2352x1568px — 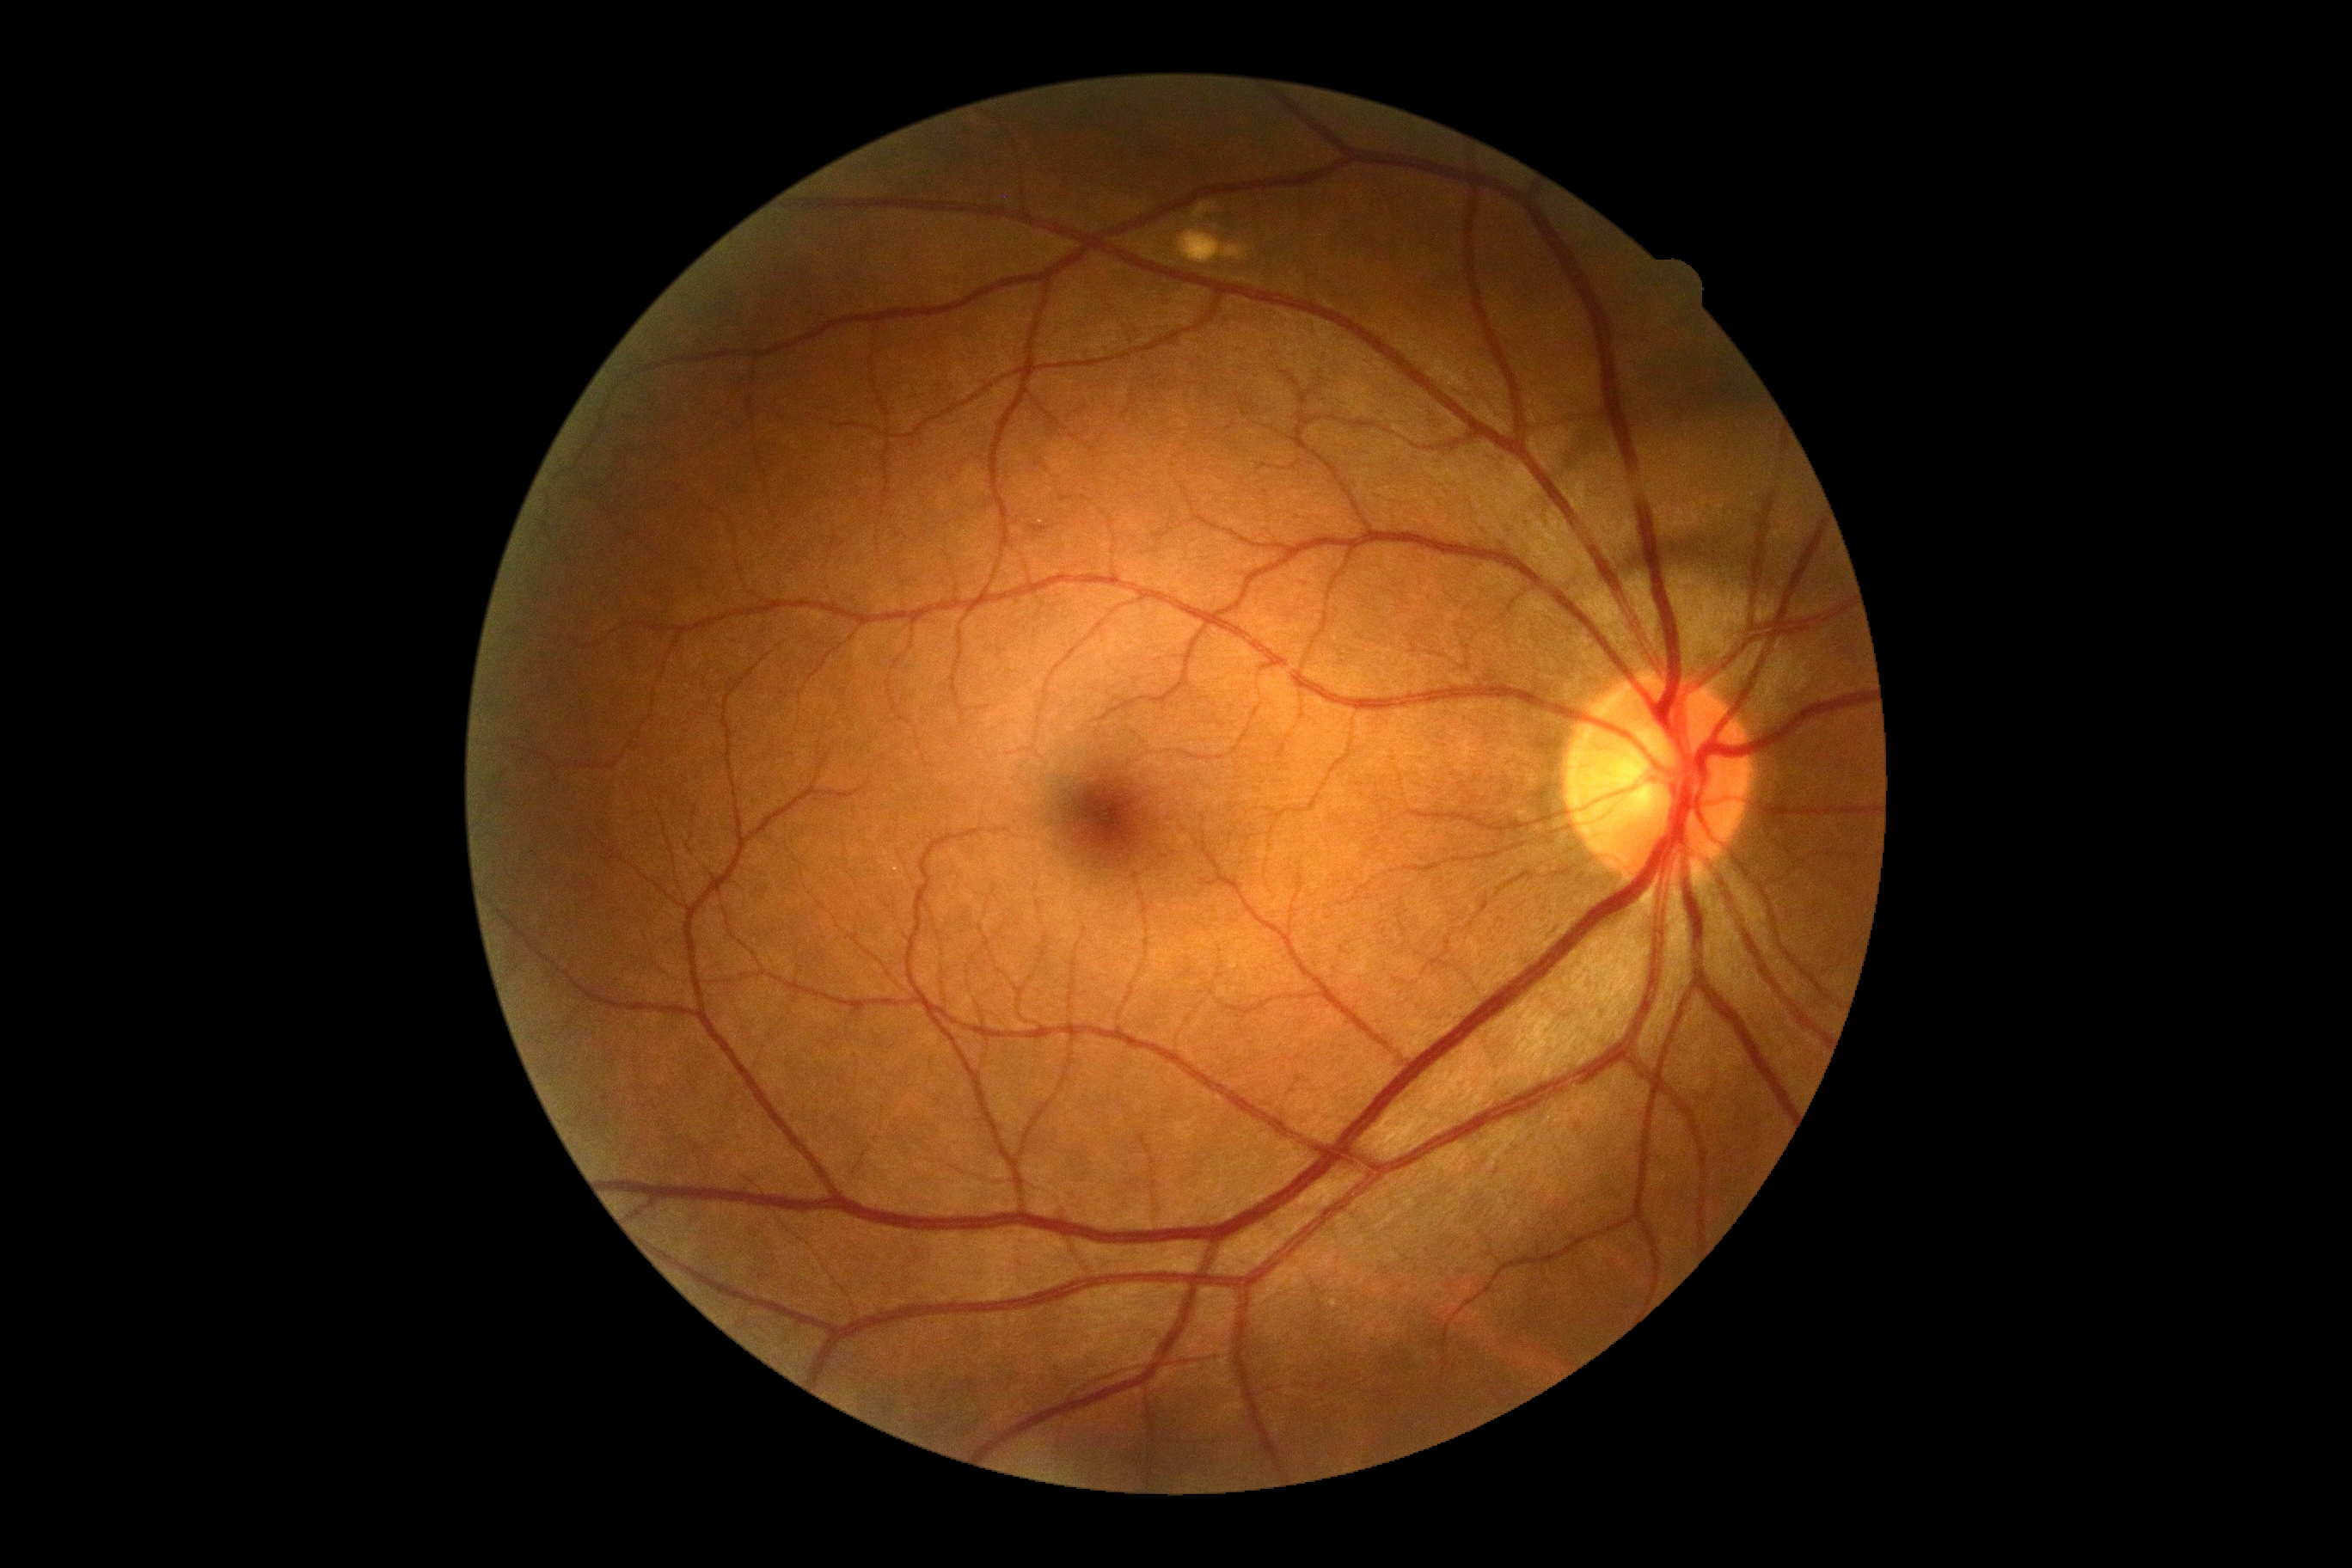

Diabetic retinopathy (DR) is grade 0 (no apparent retinopathy). No apparent diabetic retinopathy.